Nonmydriatic fundus photograph; 45 degree fundus photograph:
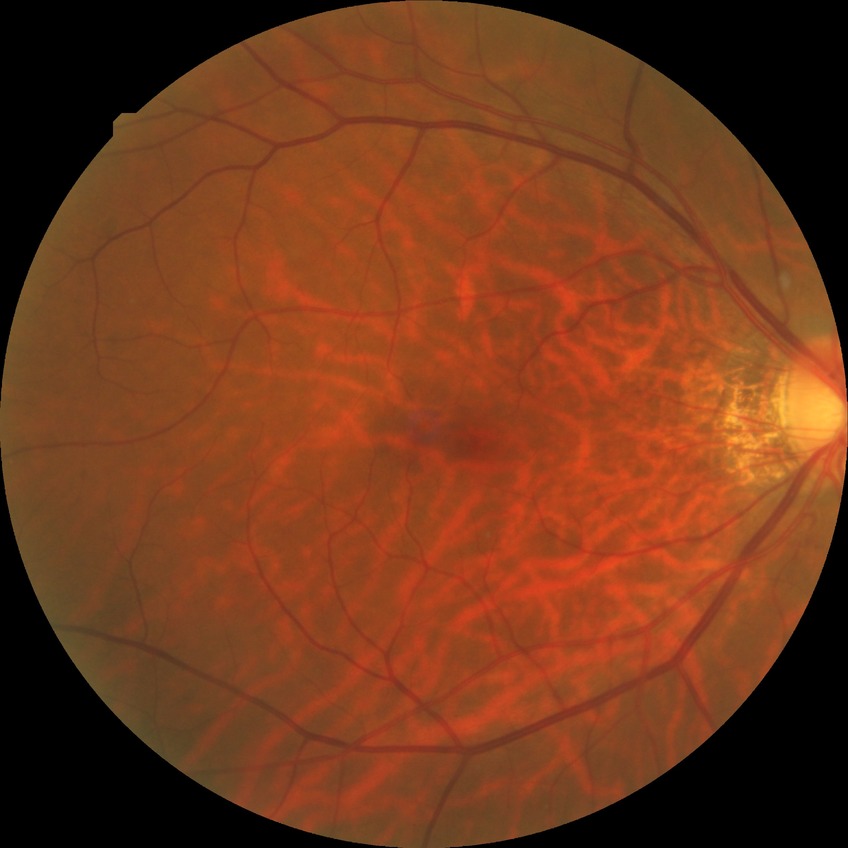 DR severity is SDR. The retinopathy is classified as non-proliferative diabetic retinopathy.